Wide-field contact fundus photograph of an infant; camera: Phoenix ICON (100° FOV); 1240x1240px.
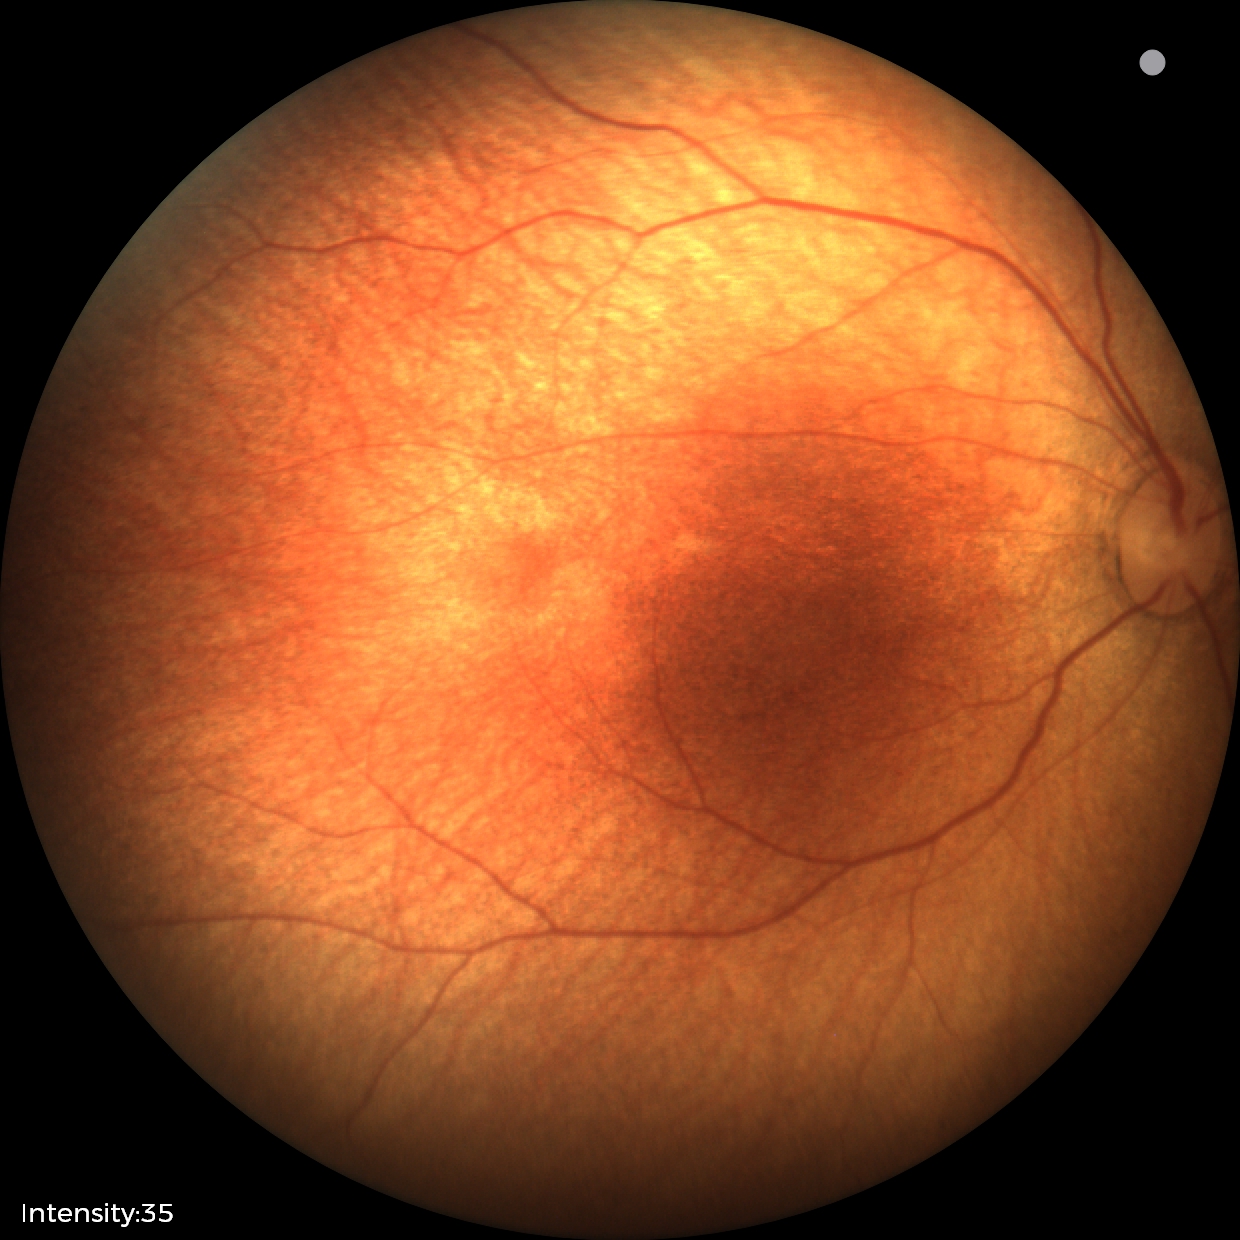 Screening examination with no abnormal retinal findings.